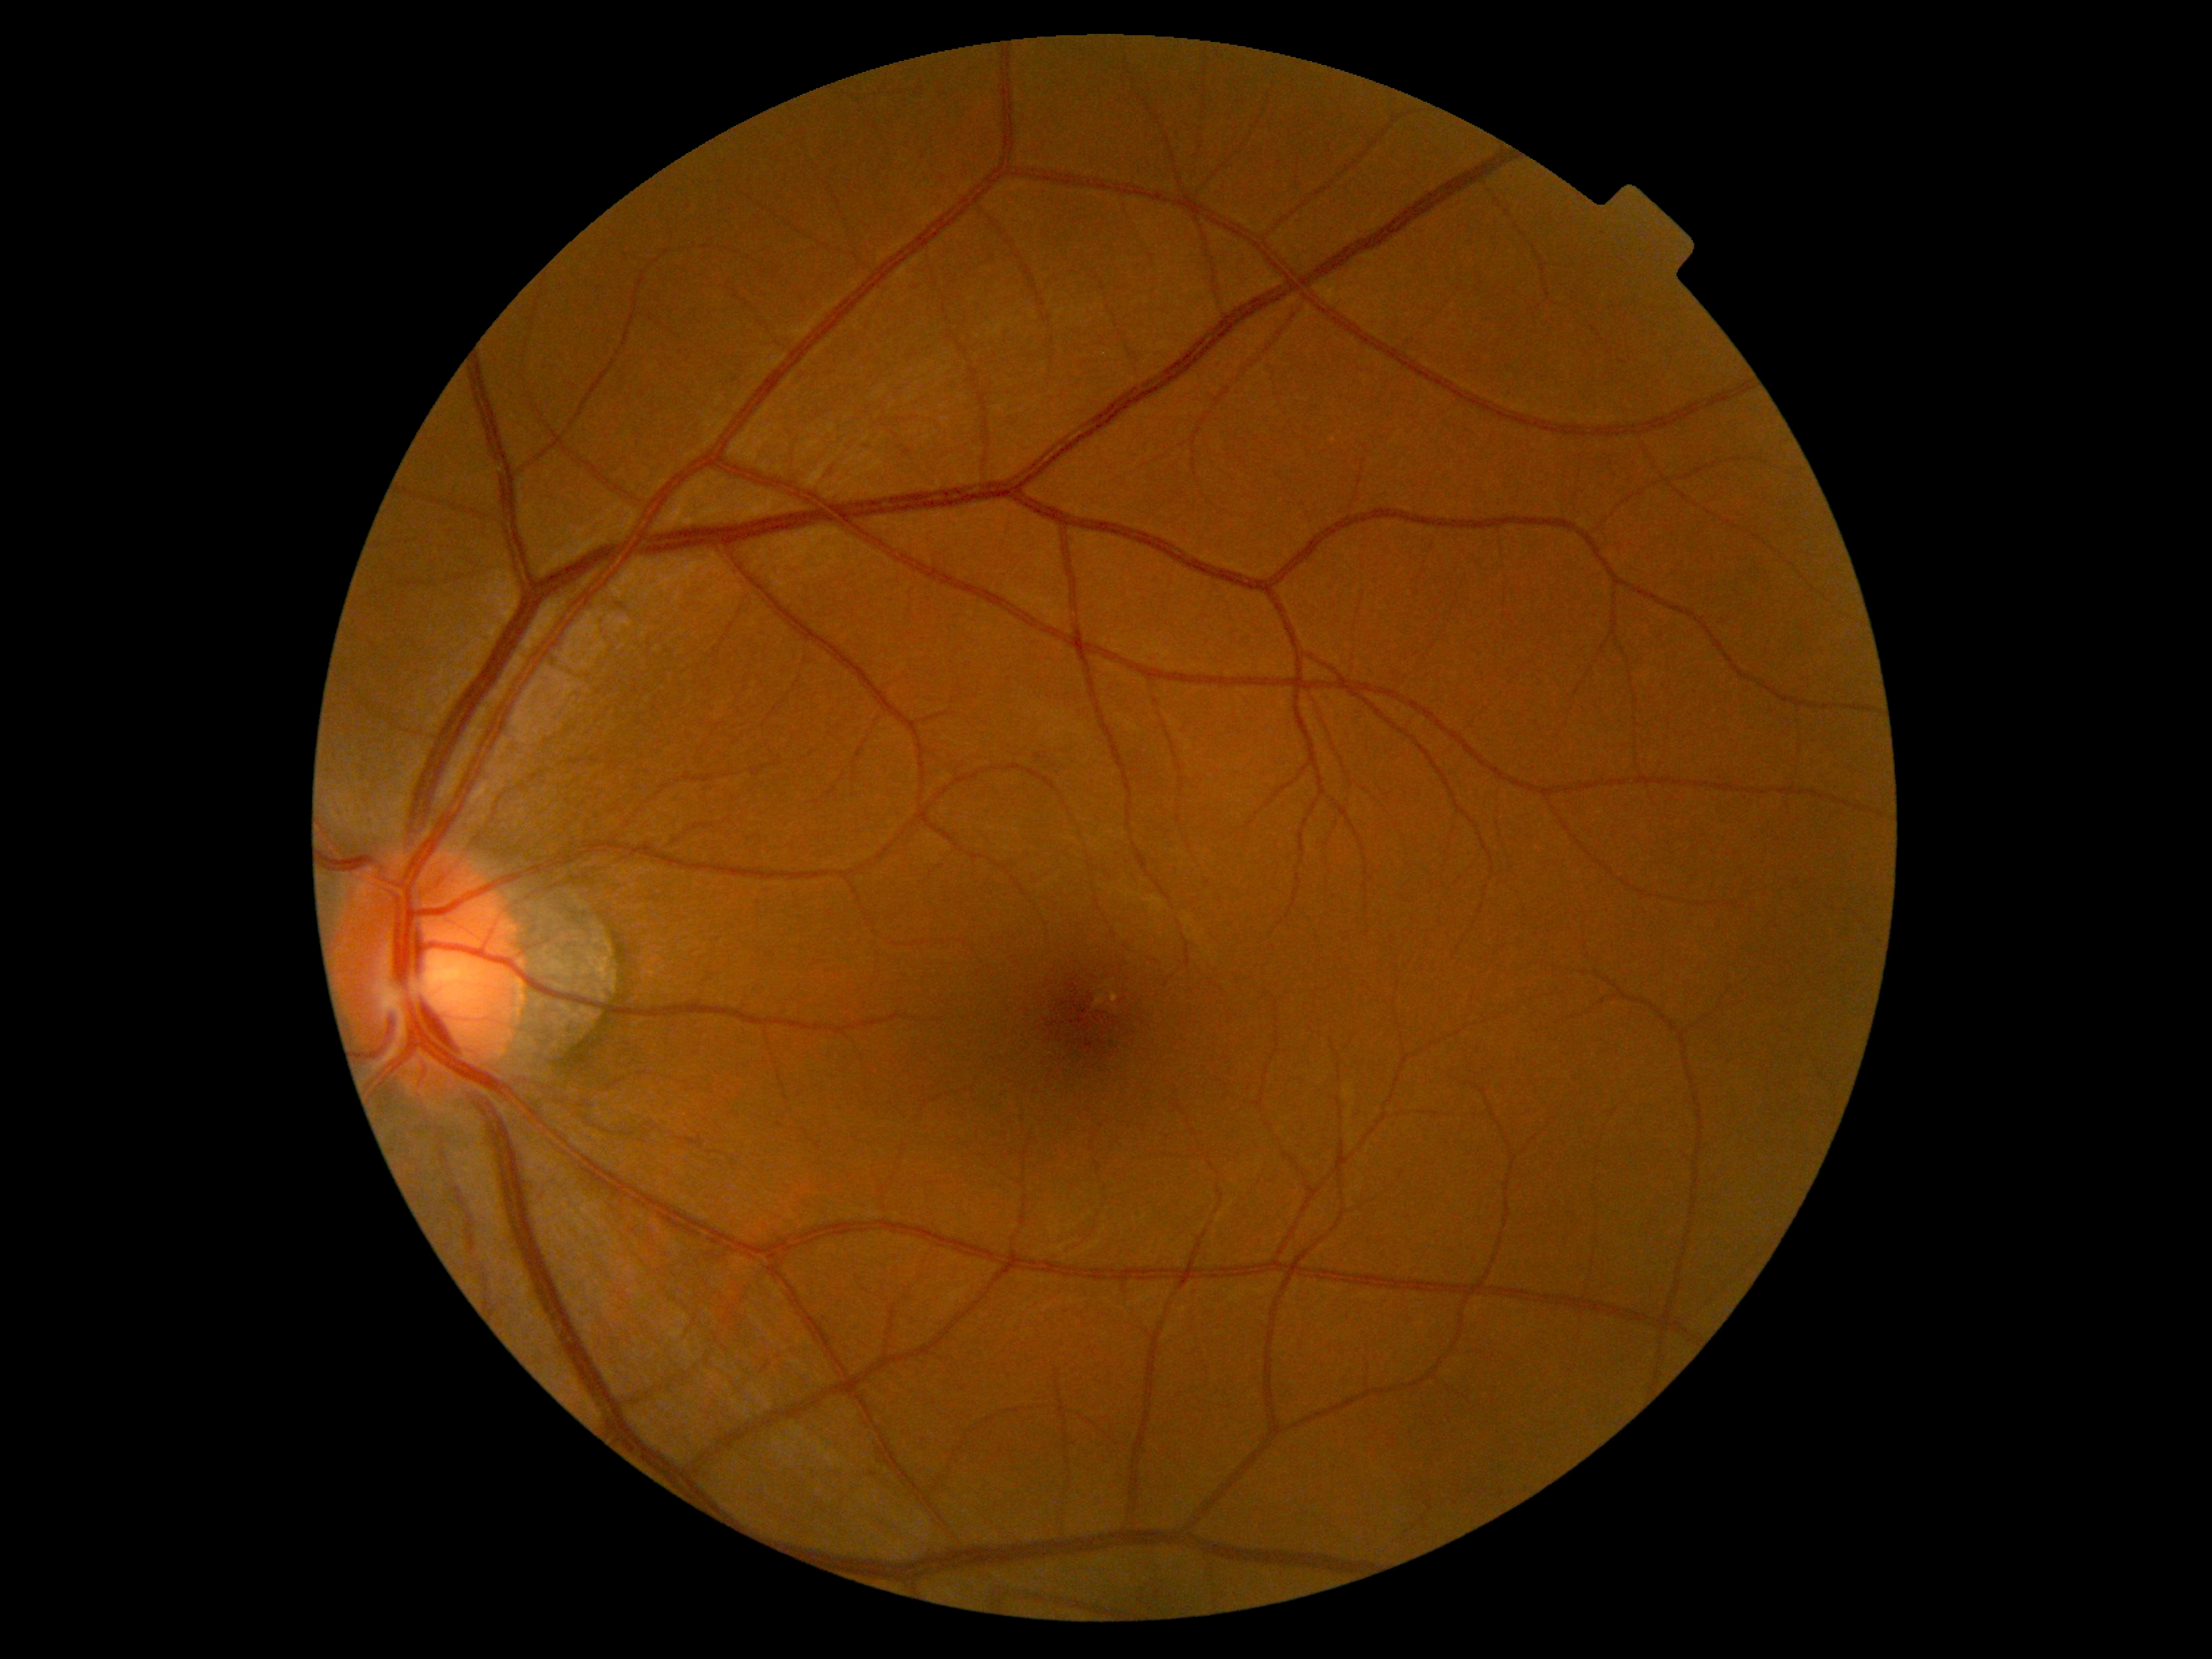

  dr_grade: 0 (no apparent retinopathy)